FOV: 50 degrees. Mydriatic (tropicamide phenylephrine 1.0%) — 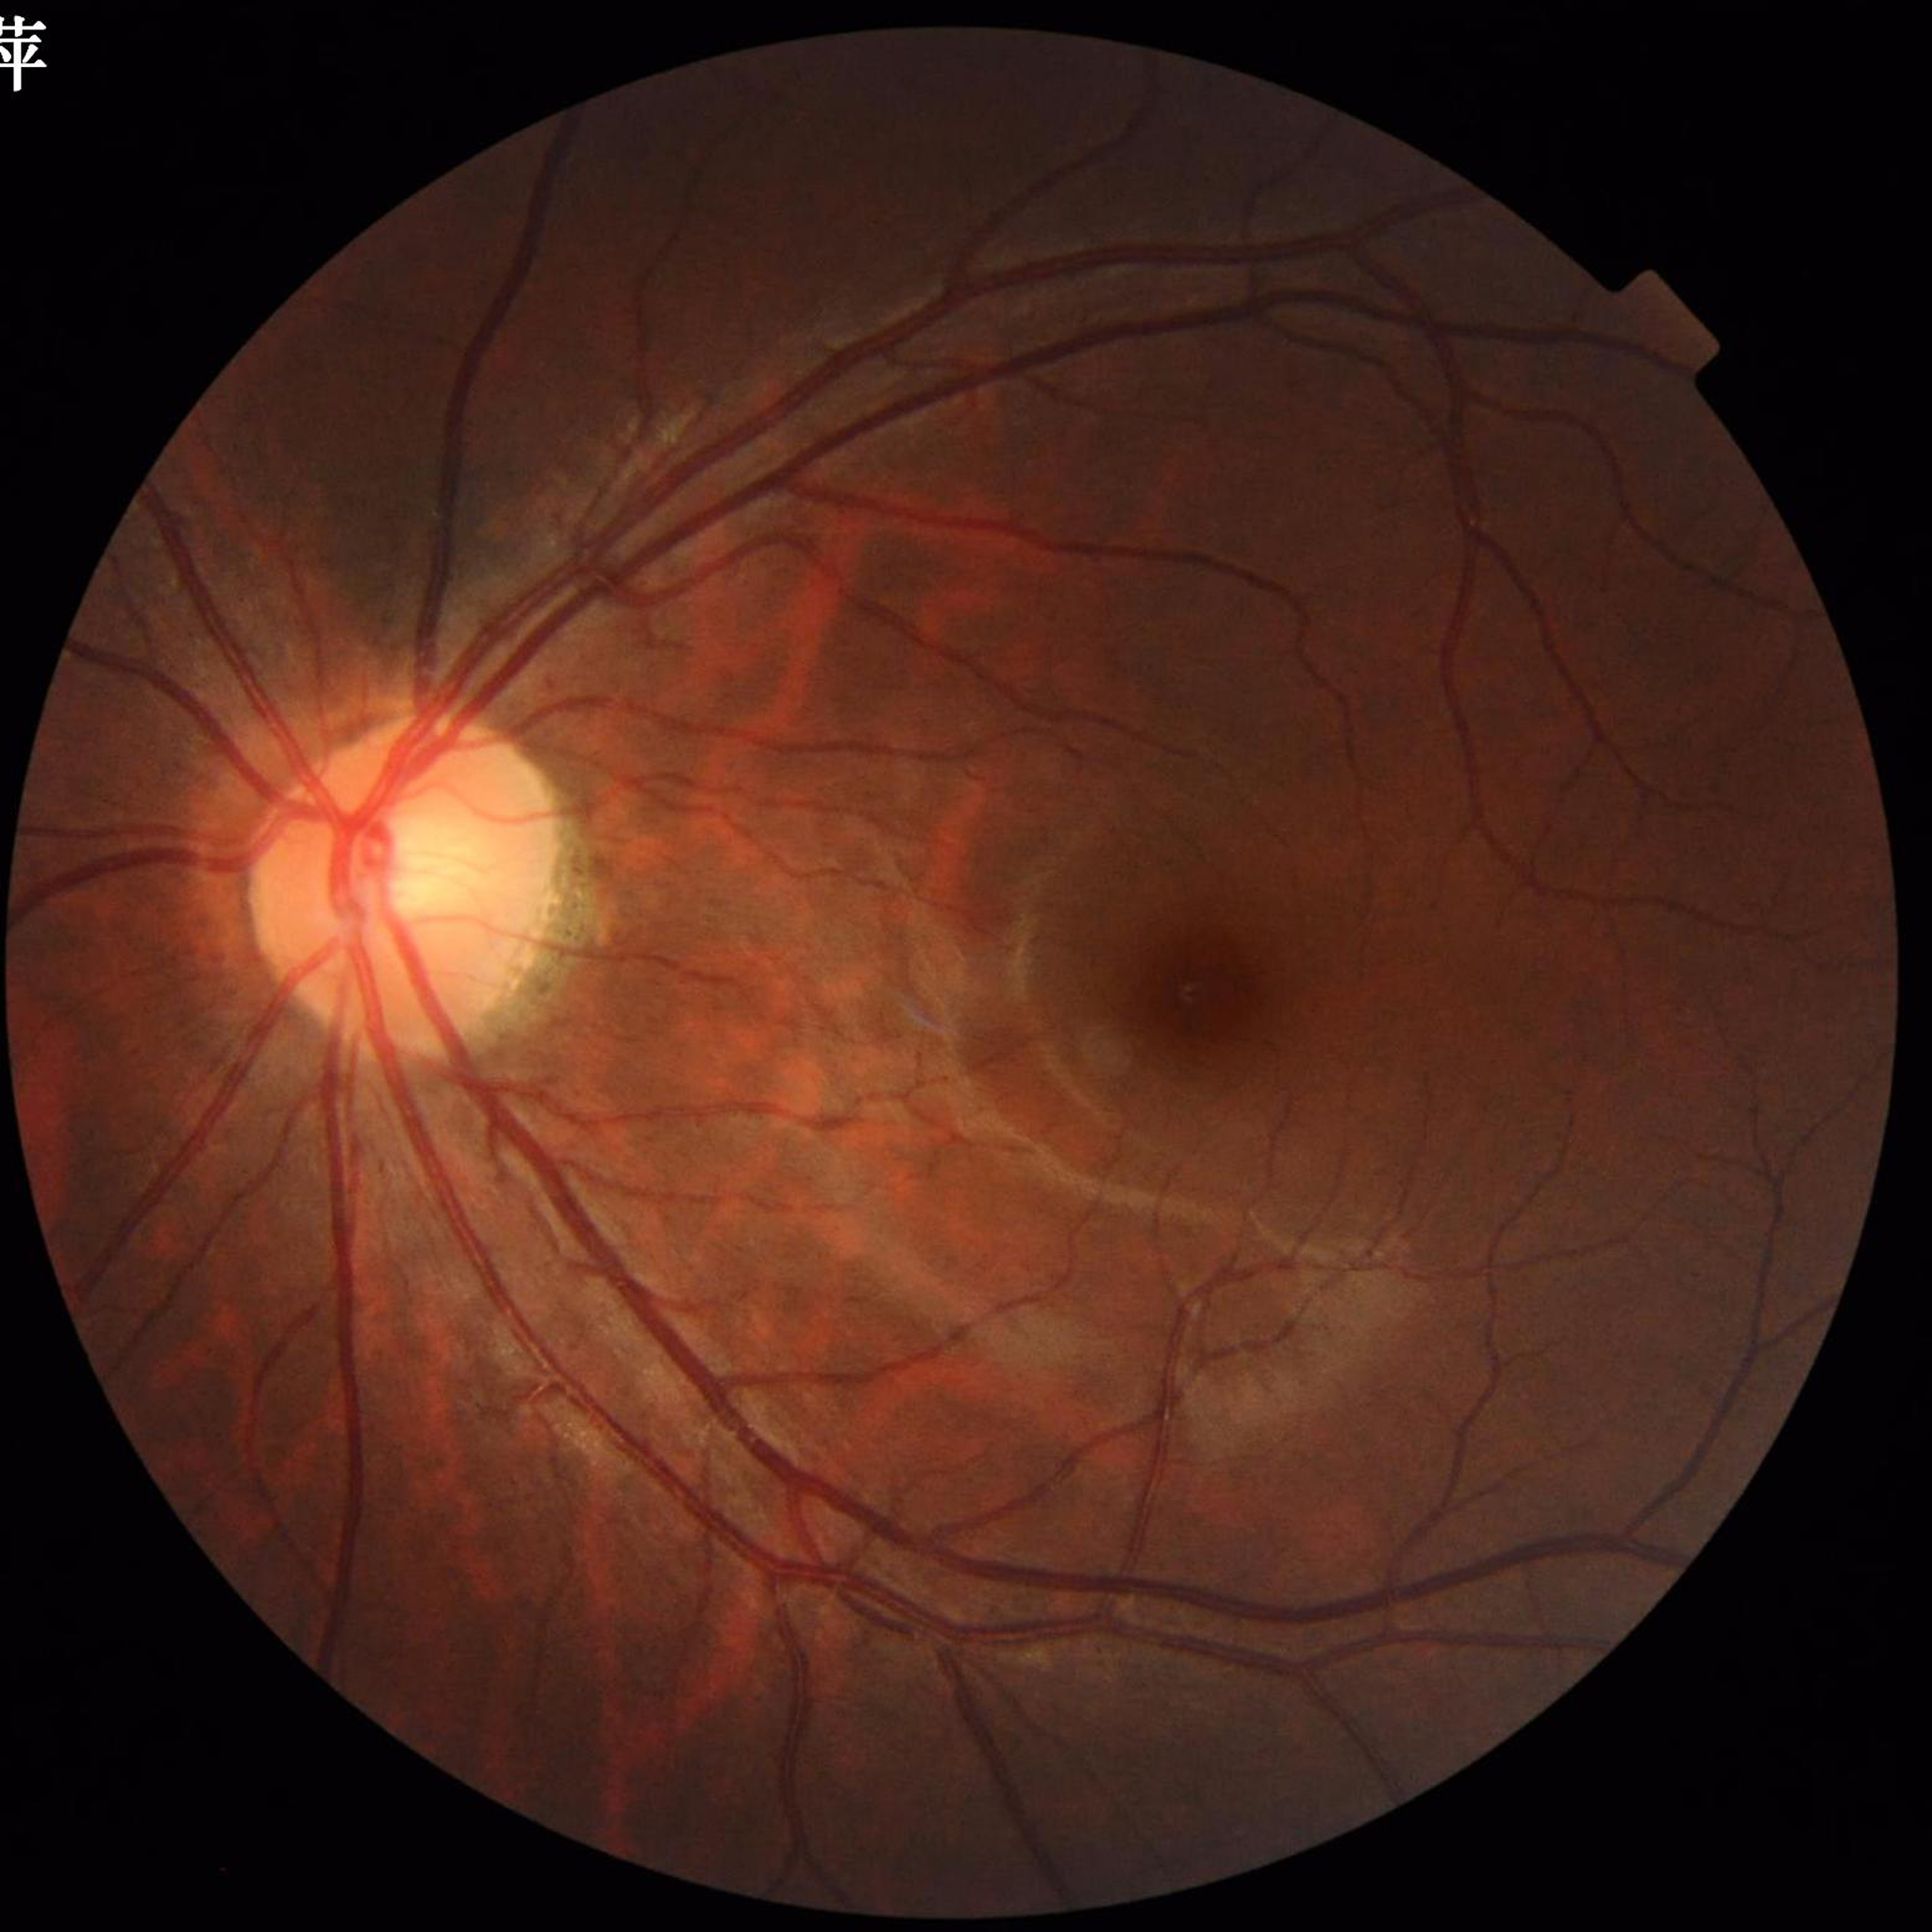
{
  "diagnosis": "no AMD, DR, or glaucomatous findings"
}